240 x 240 pixels
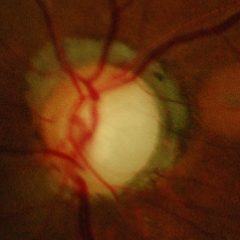
Advanced glaucoma.
Diagnostic criteria: near-total cupping of the optic nerve head, with or without severe visual field loss within the central 10 degrees of fixation.